FOV: 45 degrees:
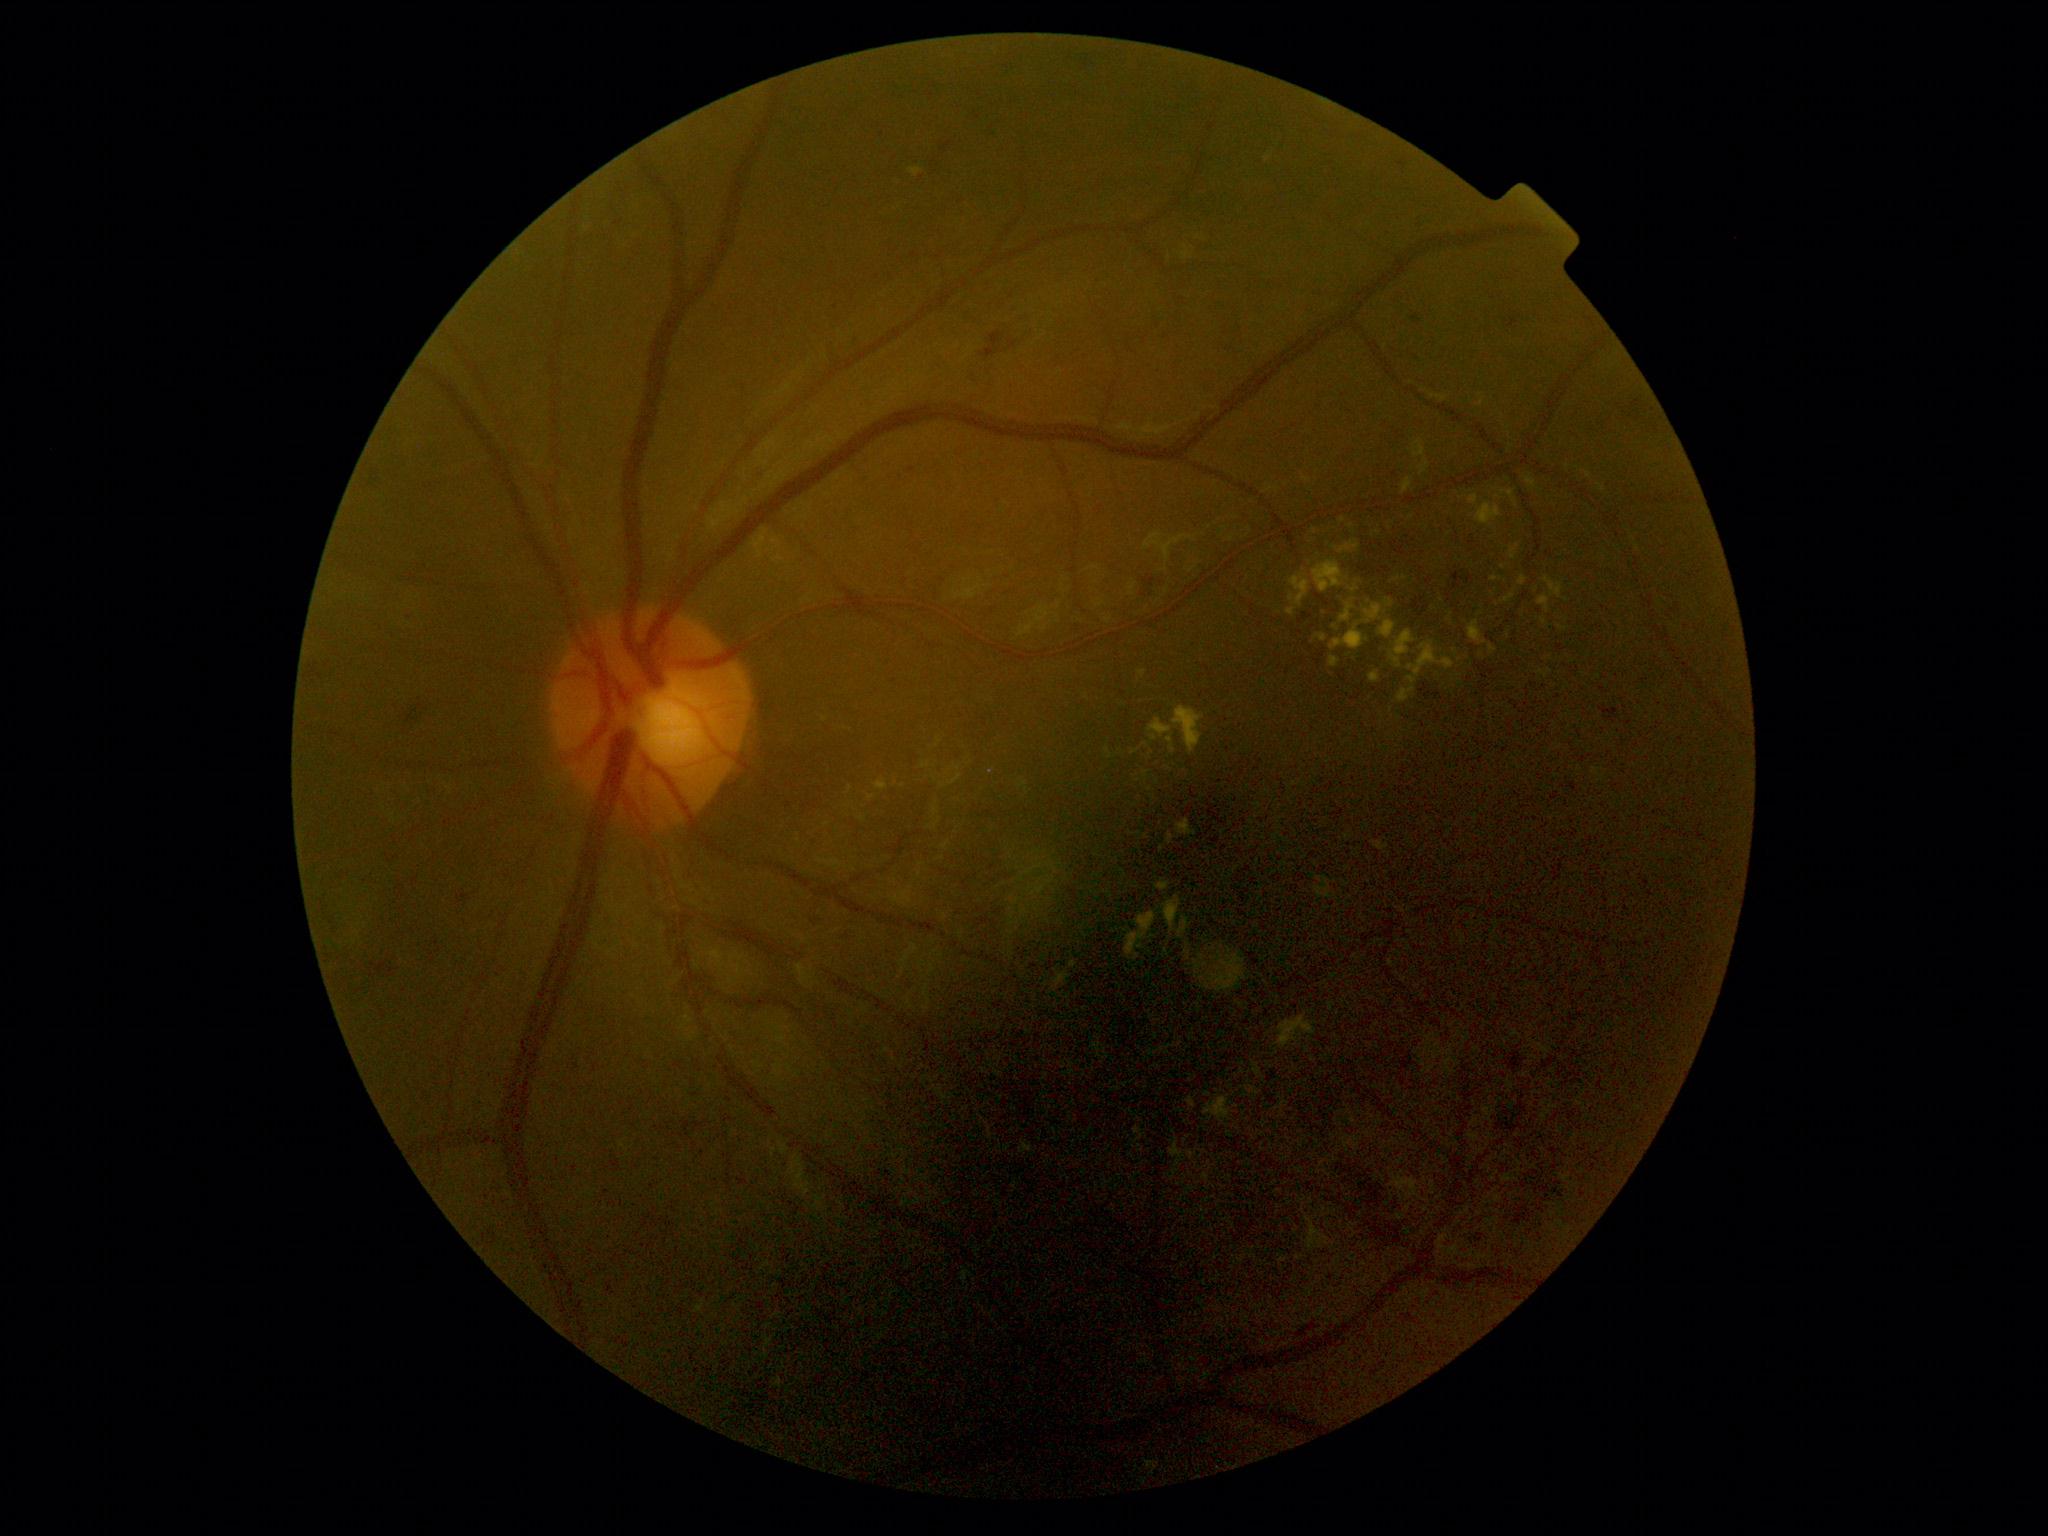
DR grade: moderate NPDR (2)
Selected lesions:
EXs (partial) = {"x1": 875, "y1": 779, "x2": 888, "y2": 792} | {"x1": 1537, "y1": 595, "x2": 1550, "y2": 613} | {"x1": 1177, "y1": 820, "x2": 1197, "y2": 836} | {"x1": 1394, "y1": 576, "x2": 1408, "y2": 583} | {"x1": 1372, "y1": 531, "x2": 1382, "y2": 537} | {"x1": 789, "y1": 1155, "x2": 810, "y2": 1197} | {"x1": 1138, "y1": 671, "x2": 1148, "y2": 679} | {"x1": 1187, "y1": 1097, "x2": 1197, "y2": 1109} | {"x1": 1313, "y1": 560, "x2": 1349, "y2": 593} | {"x1": 753, "y1": 529, "x2": 767, "y2": 559}
Smaller EXs around [1352,527] | [1499,498] | [1087,699] | [1567,600] | [1412,518] | [1544,622] | [1459,660]